RetCam wide-field infant fundus image; 1440x1080px
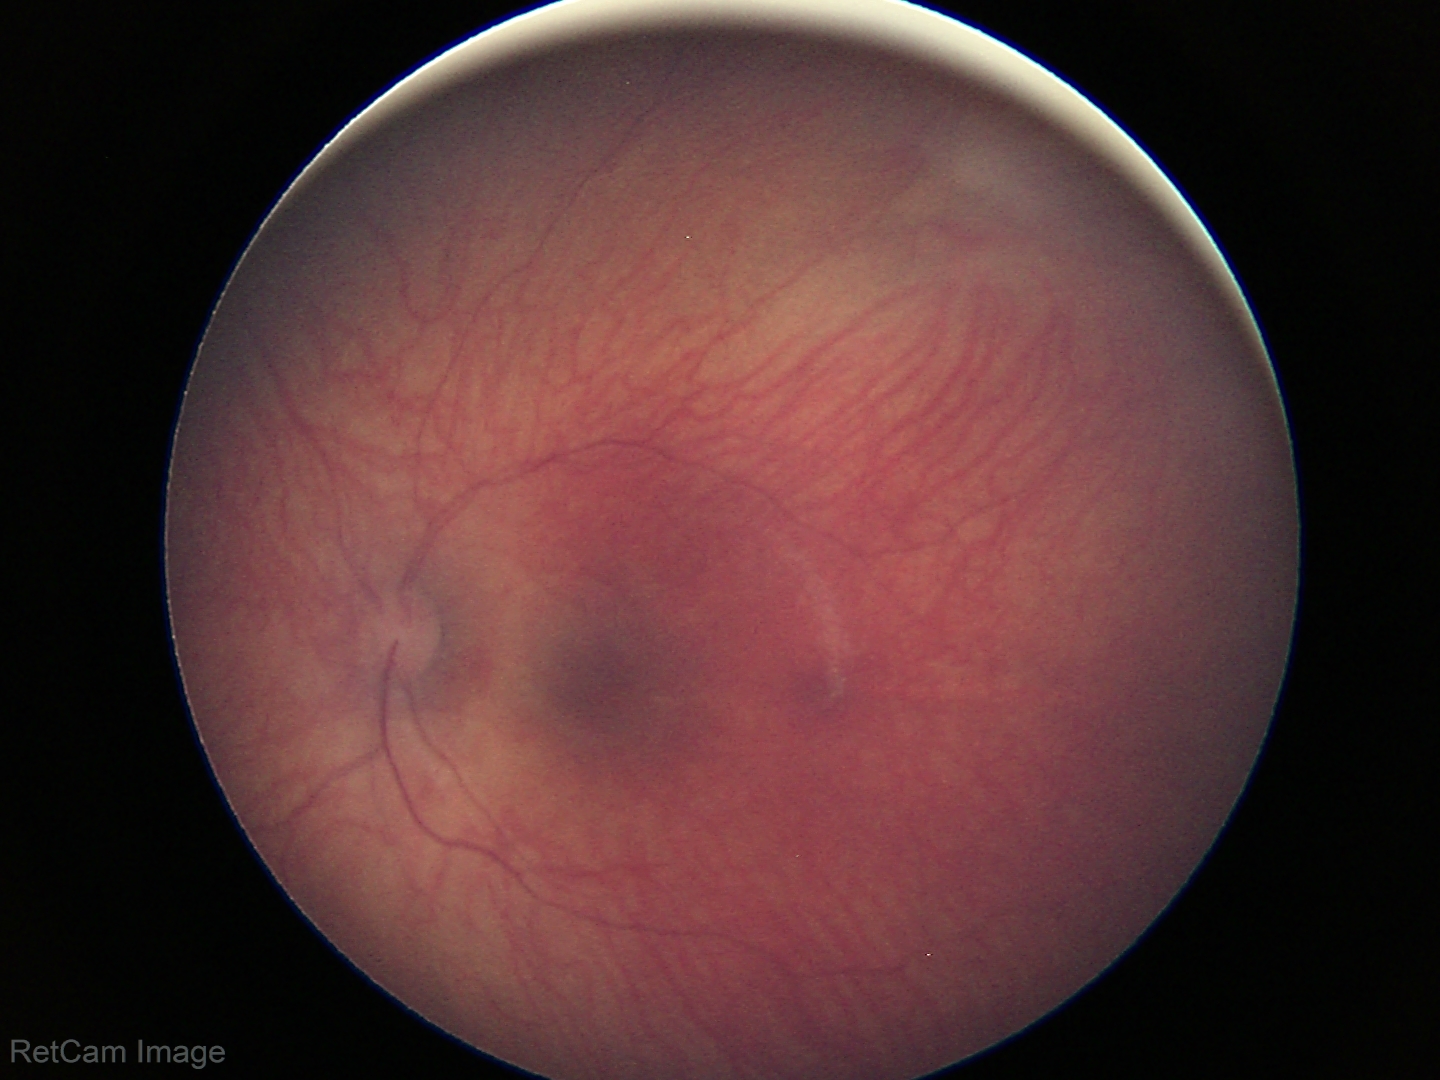

No retinal pathology identified on screening.